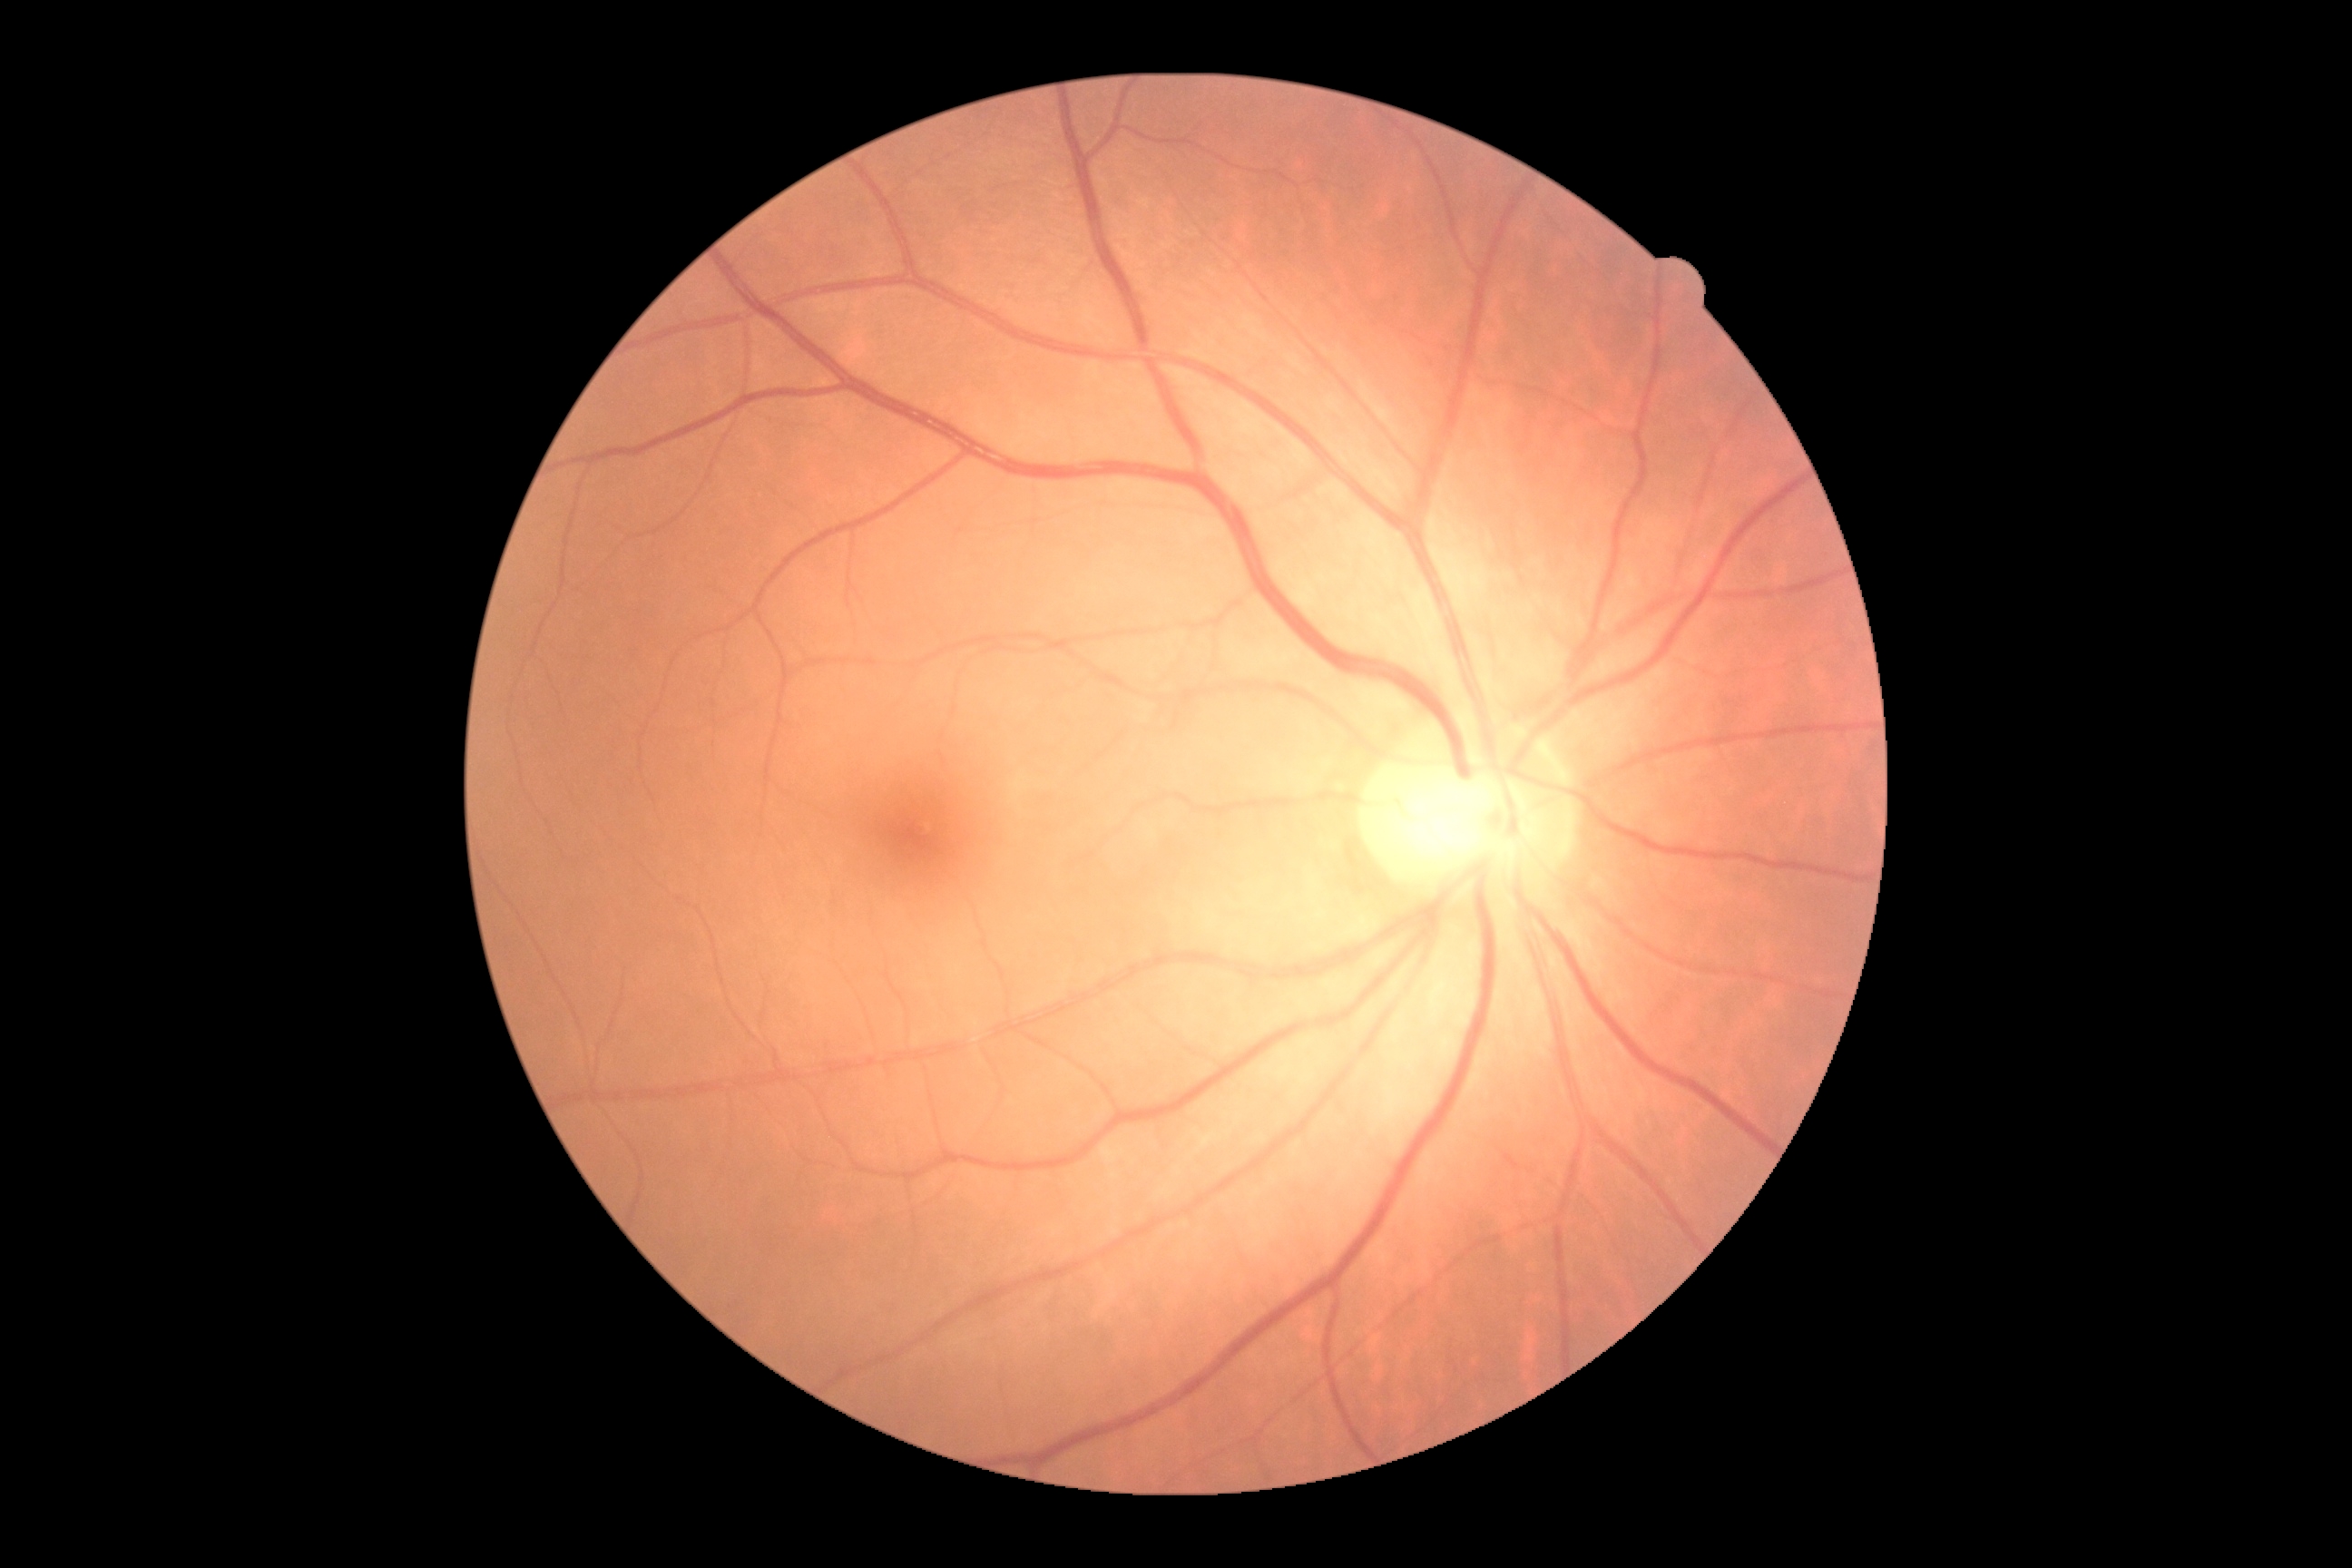 dr_grade: grade 0 (no apparent retinopathy)